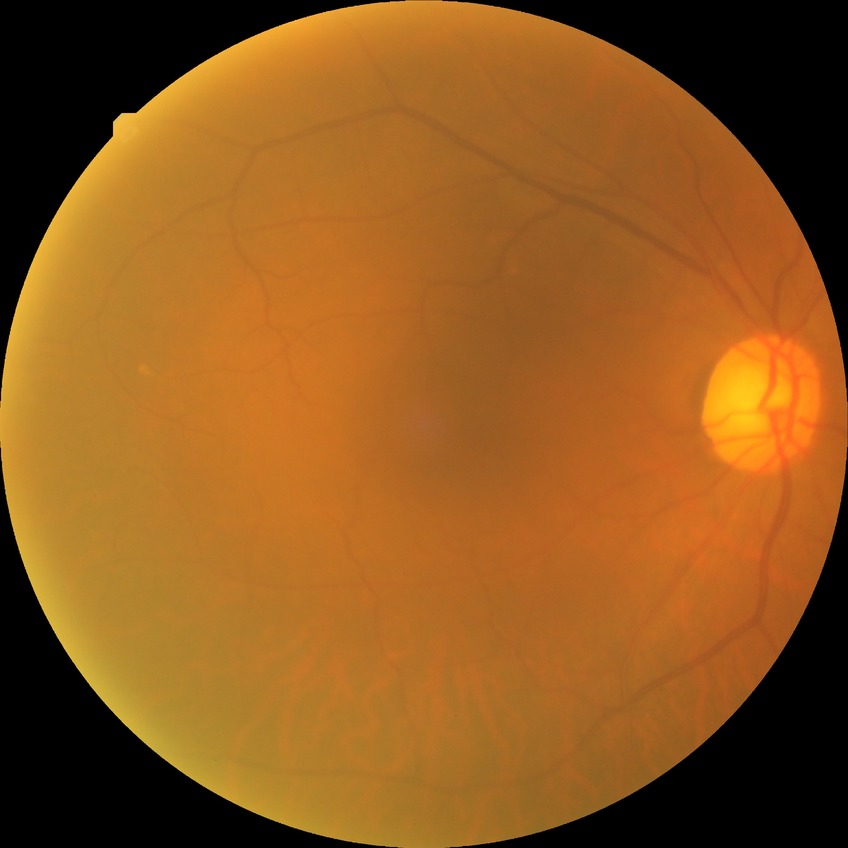

diabetic retinopathy (DR)@NDR (no diabetic retinopathy).